Wide-field fundus photograph of an infant; 100° field of view (Phoenix ICON) — 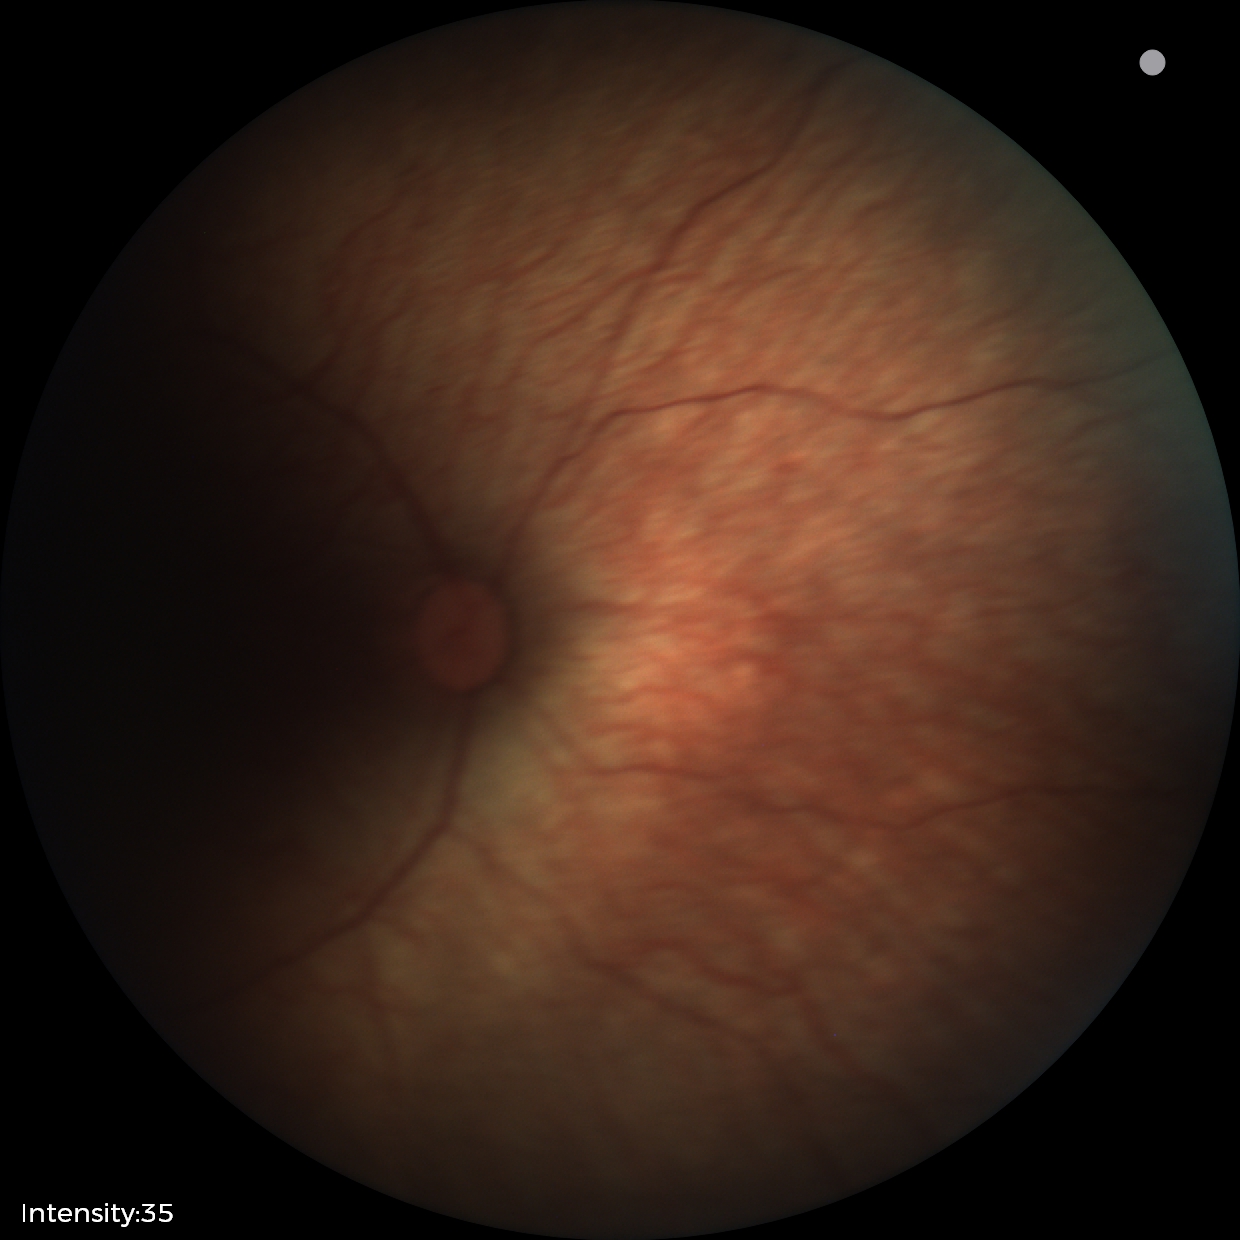 Physiological retinal appearance for postconceptual age.